100° field of view (Phoenix ICON) · Phoenix ICON wide-field infant fundus image: 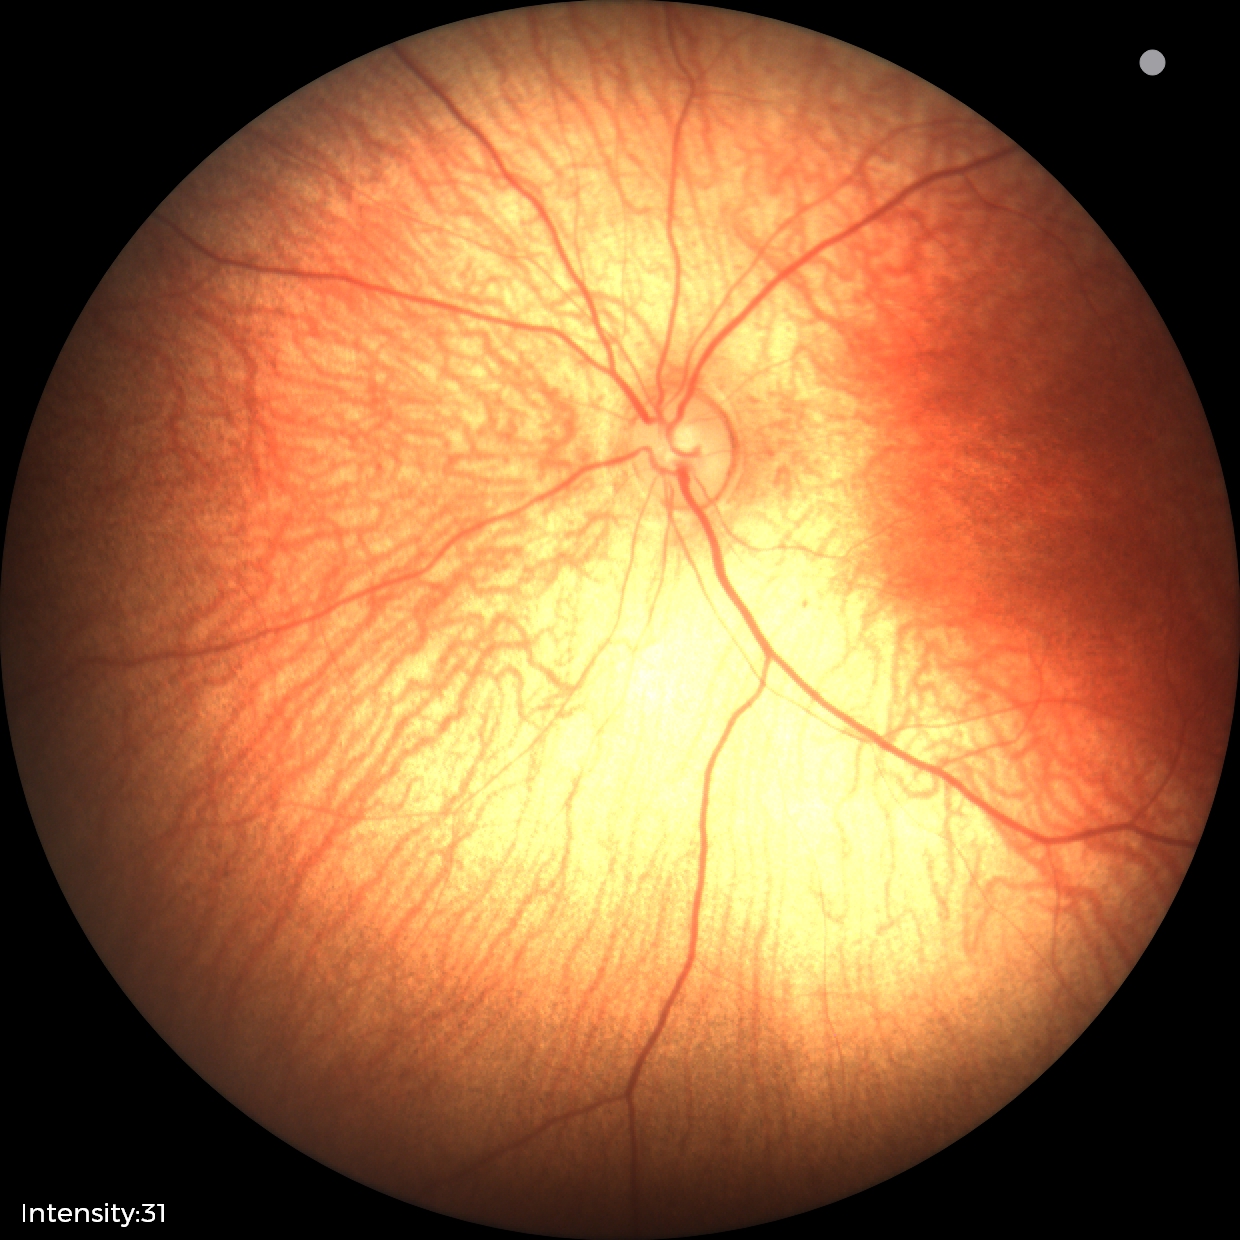
Screening examination with no abnormal retinal findings.